848 by 848 pixels; modified Davis classification
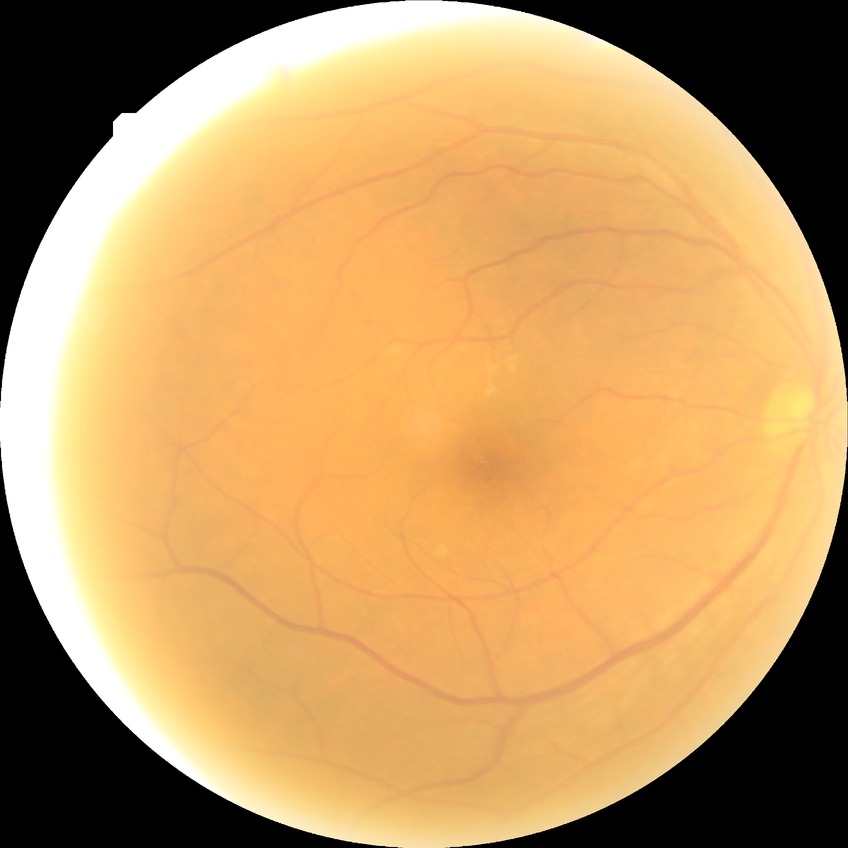 Modified Davis grading: no diabetic retinopathy.